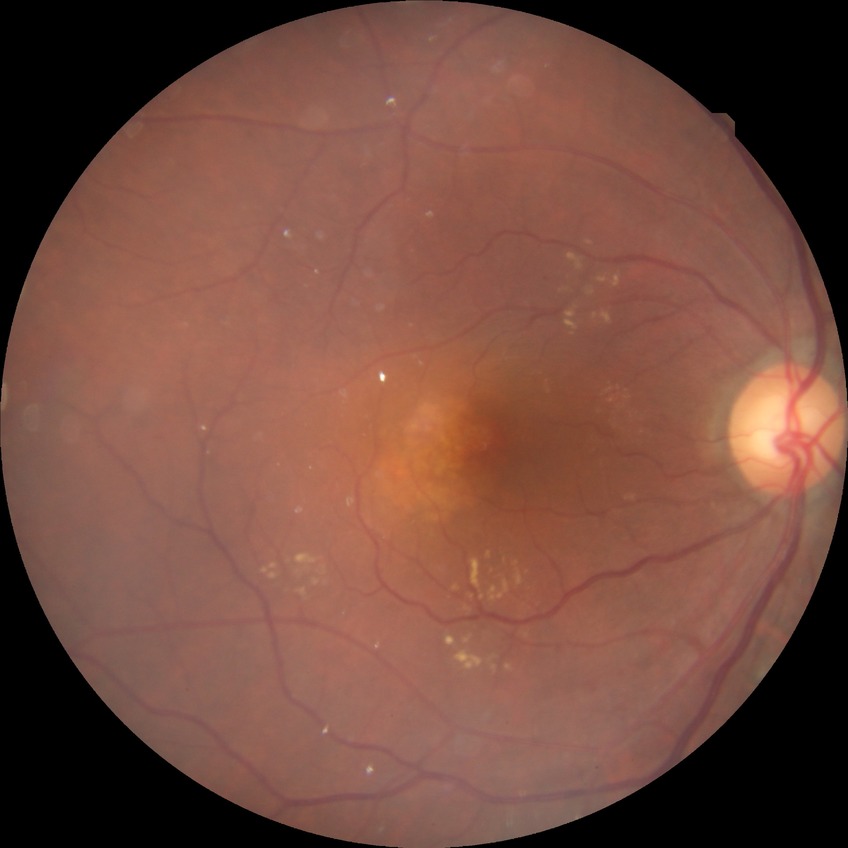 DR class: non-proliferative diabetic retinopathy | modified Davis grading: simple diabetic retinopathy.